Wide-field fundus photograph from neonatal ROP screening:
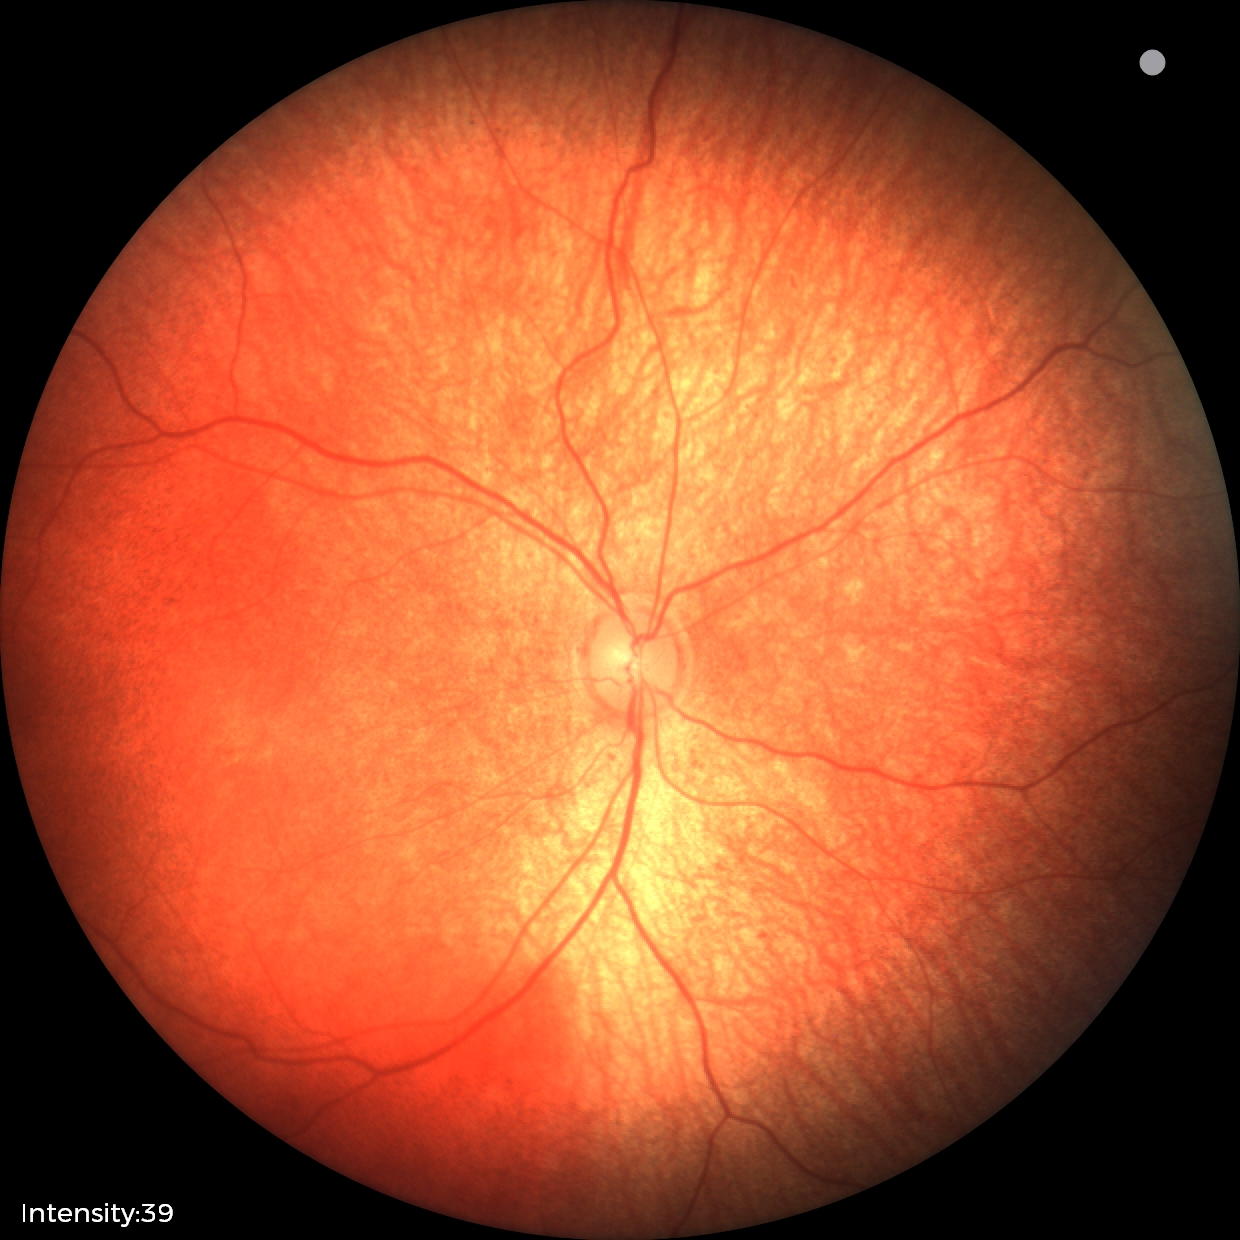
Screening examination diagnosed as physiological.